Without pupil dilation.
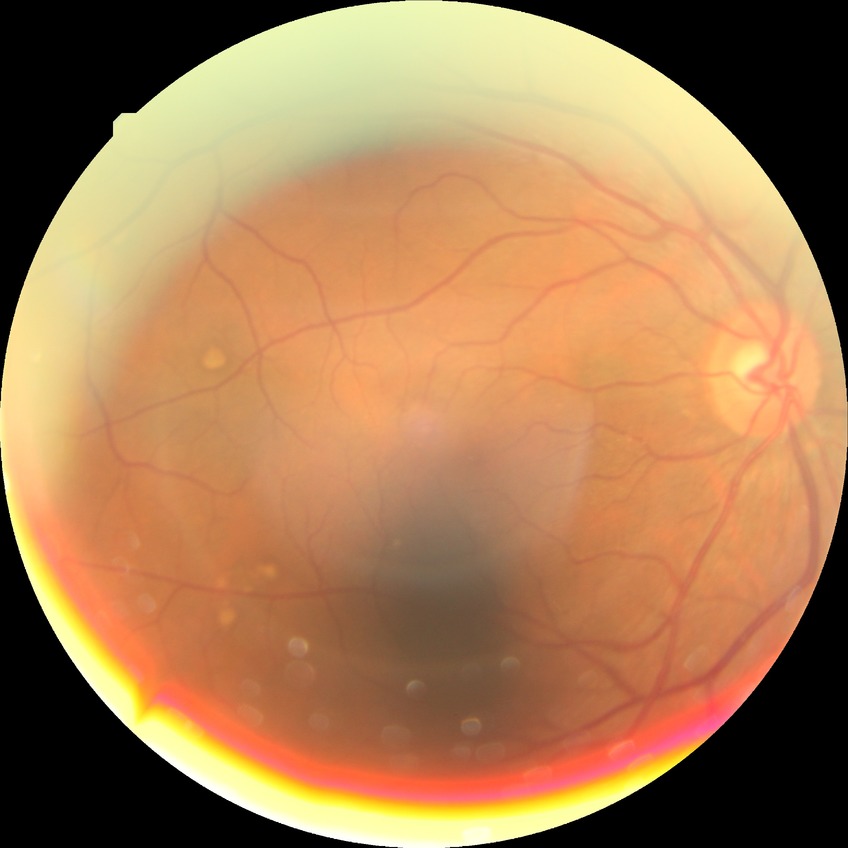

retinopathy grade: no diabetic retinopathy.